848x848; retinal fundus photograph; nonmydriatic fundus photograph; NIDEK AFC-230; 45° field of view: 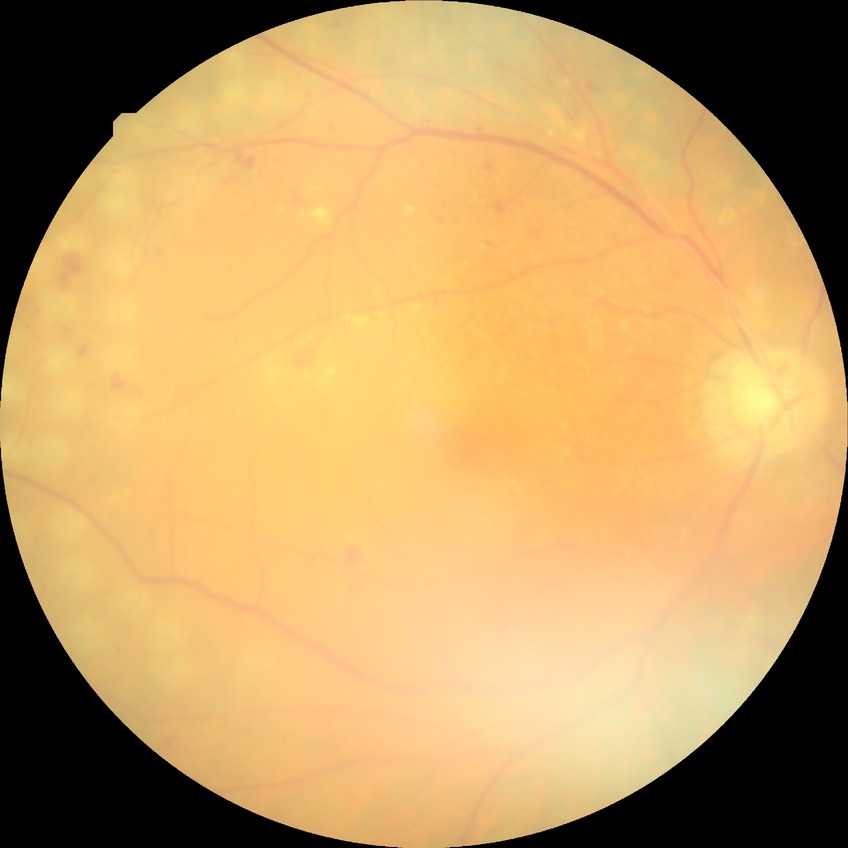
diabetic retinopathy grade = proliferative diabetic retinopathy.